FOV: 50 degrees — 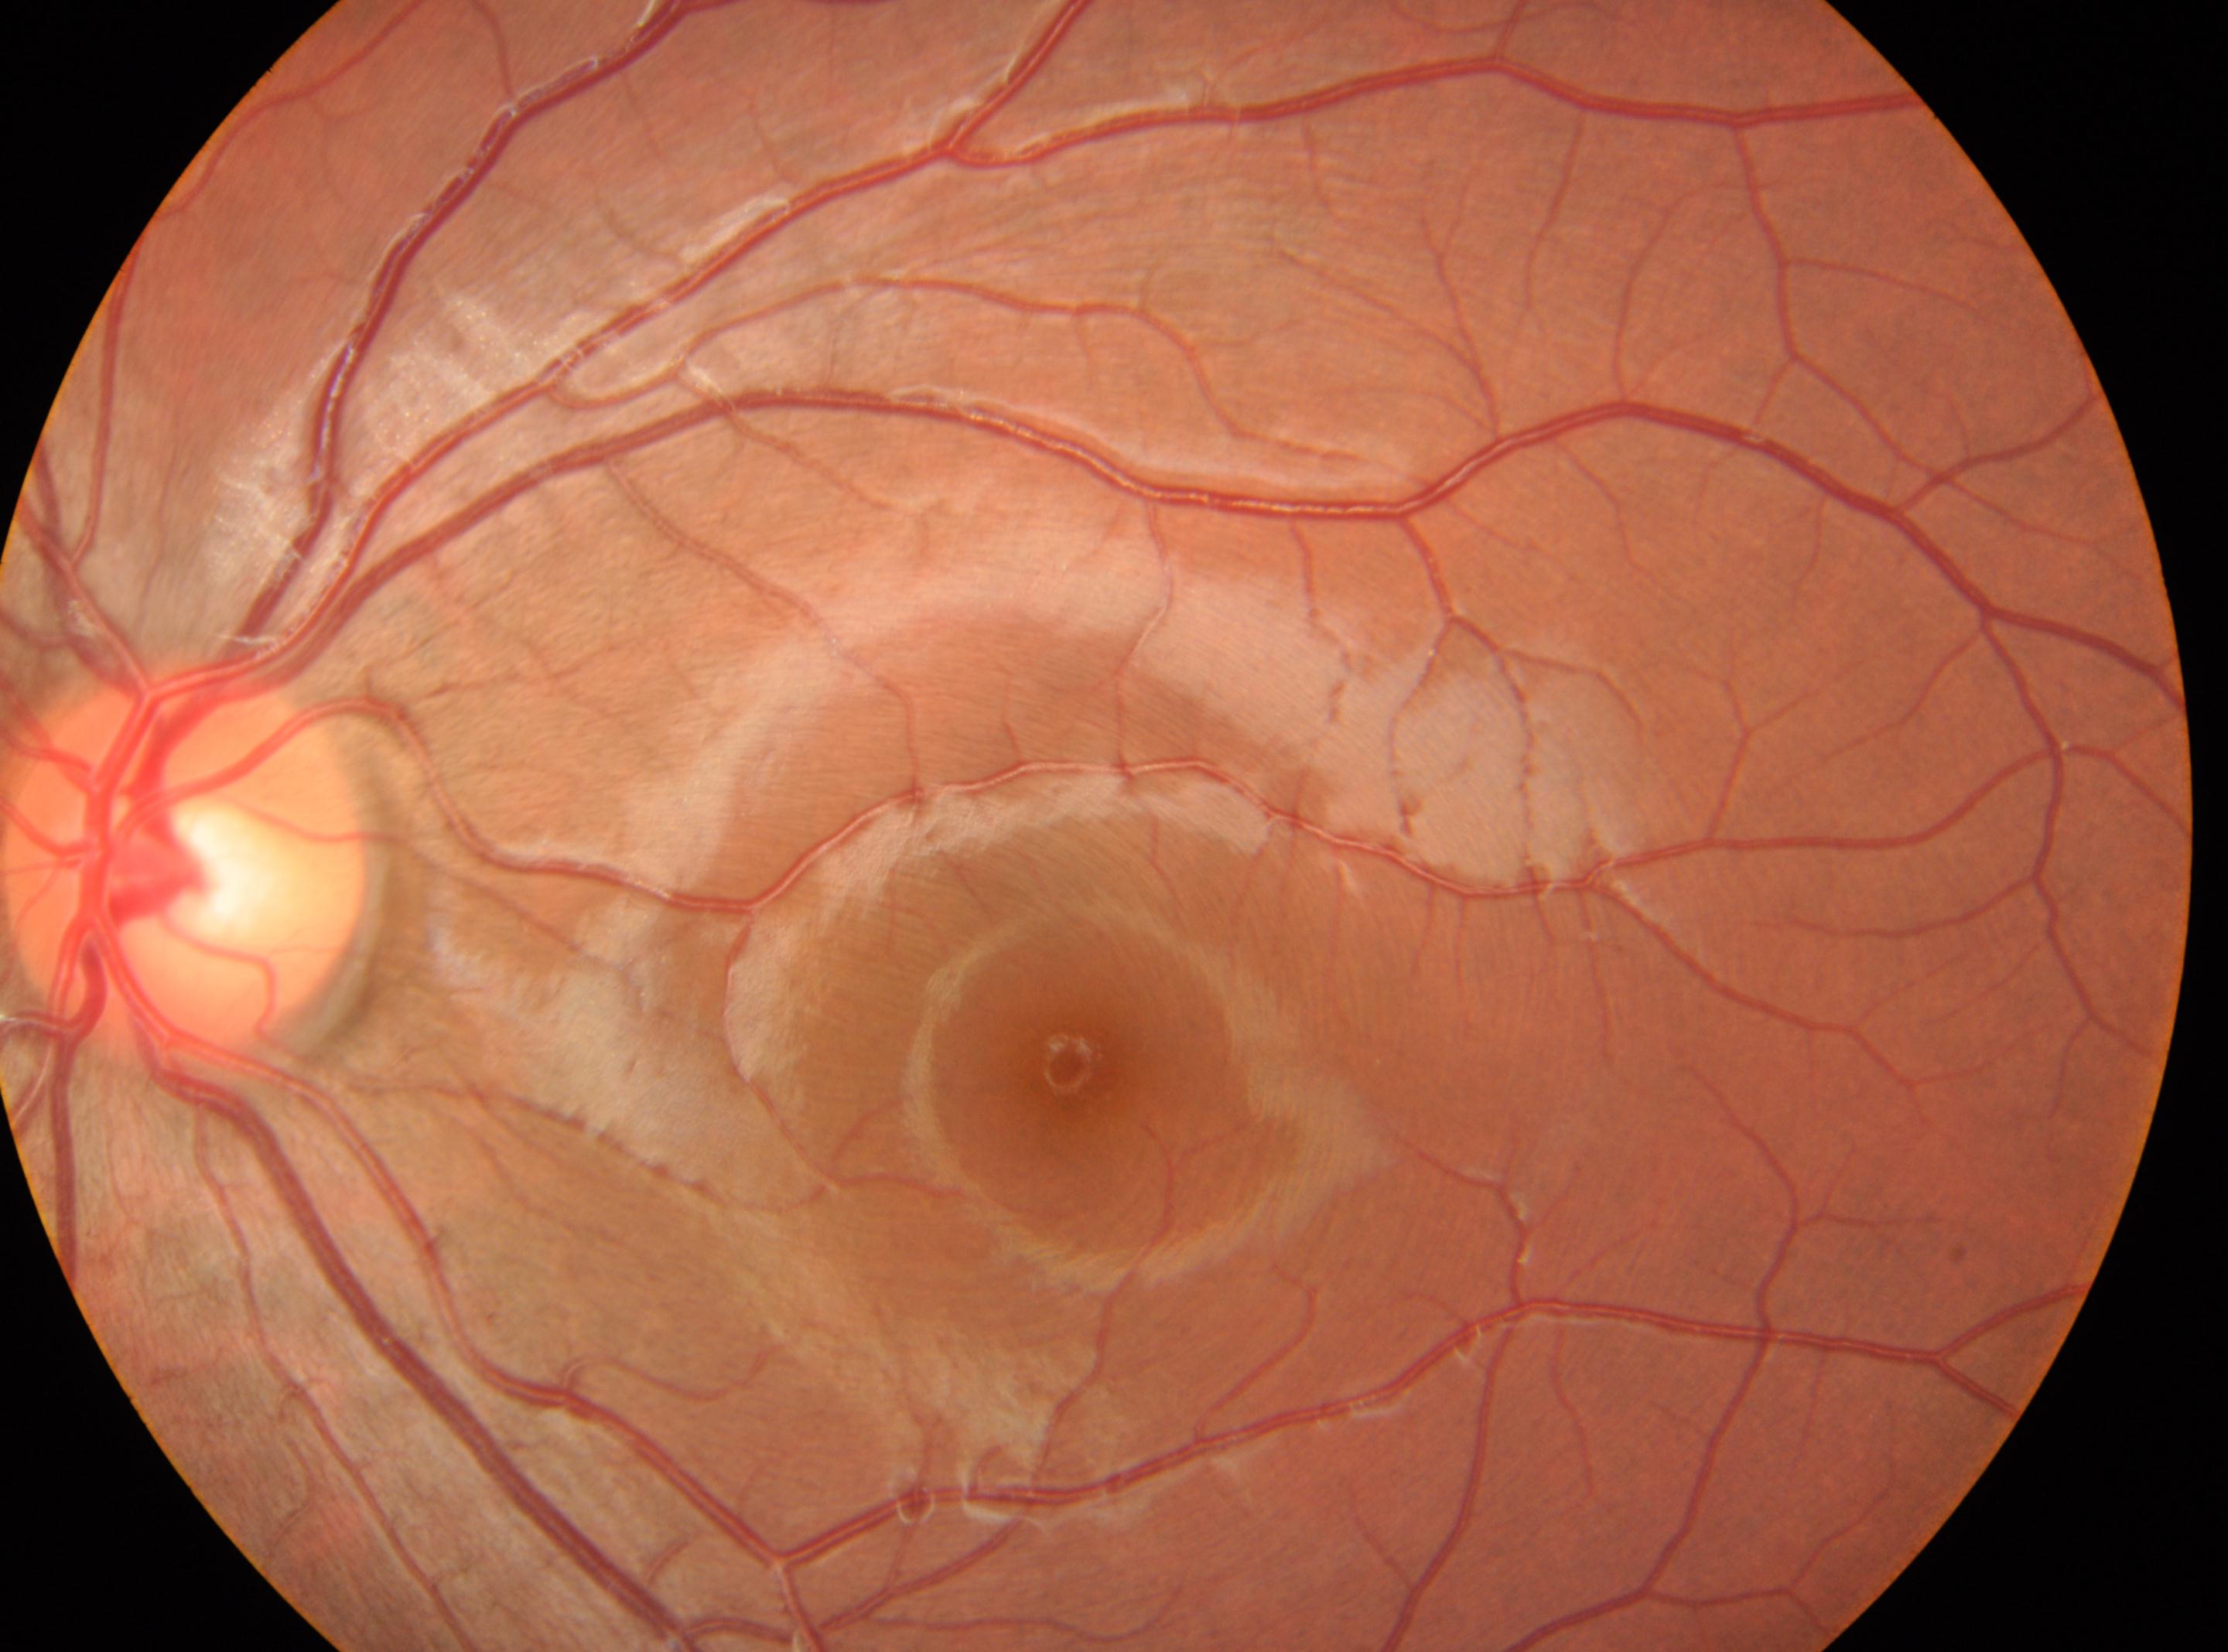 ONH located at 187, 860. DR stage: grade 0. Eye: left. Fovea centralis located at 1078, 1066.